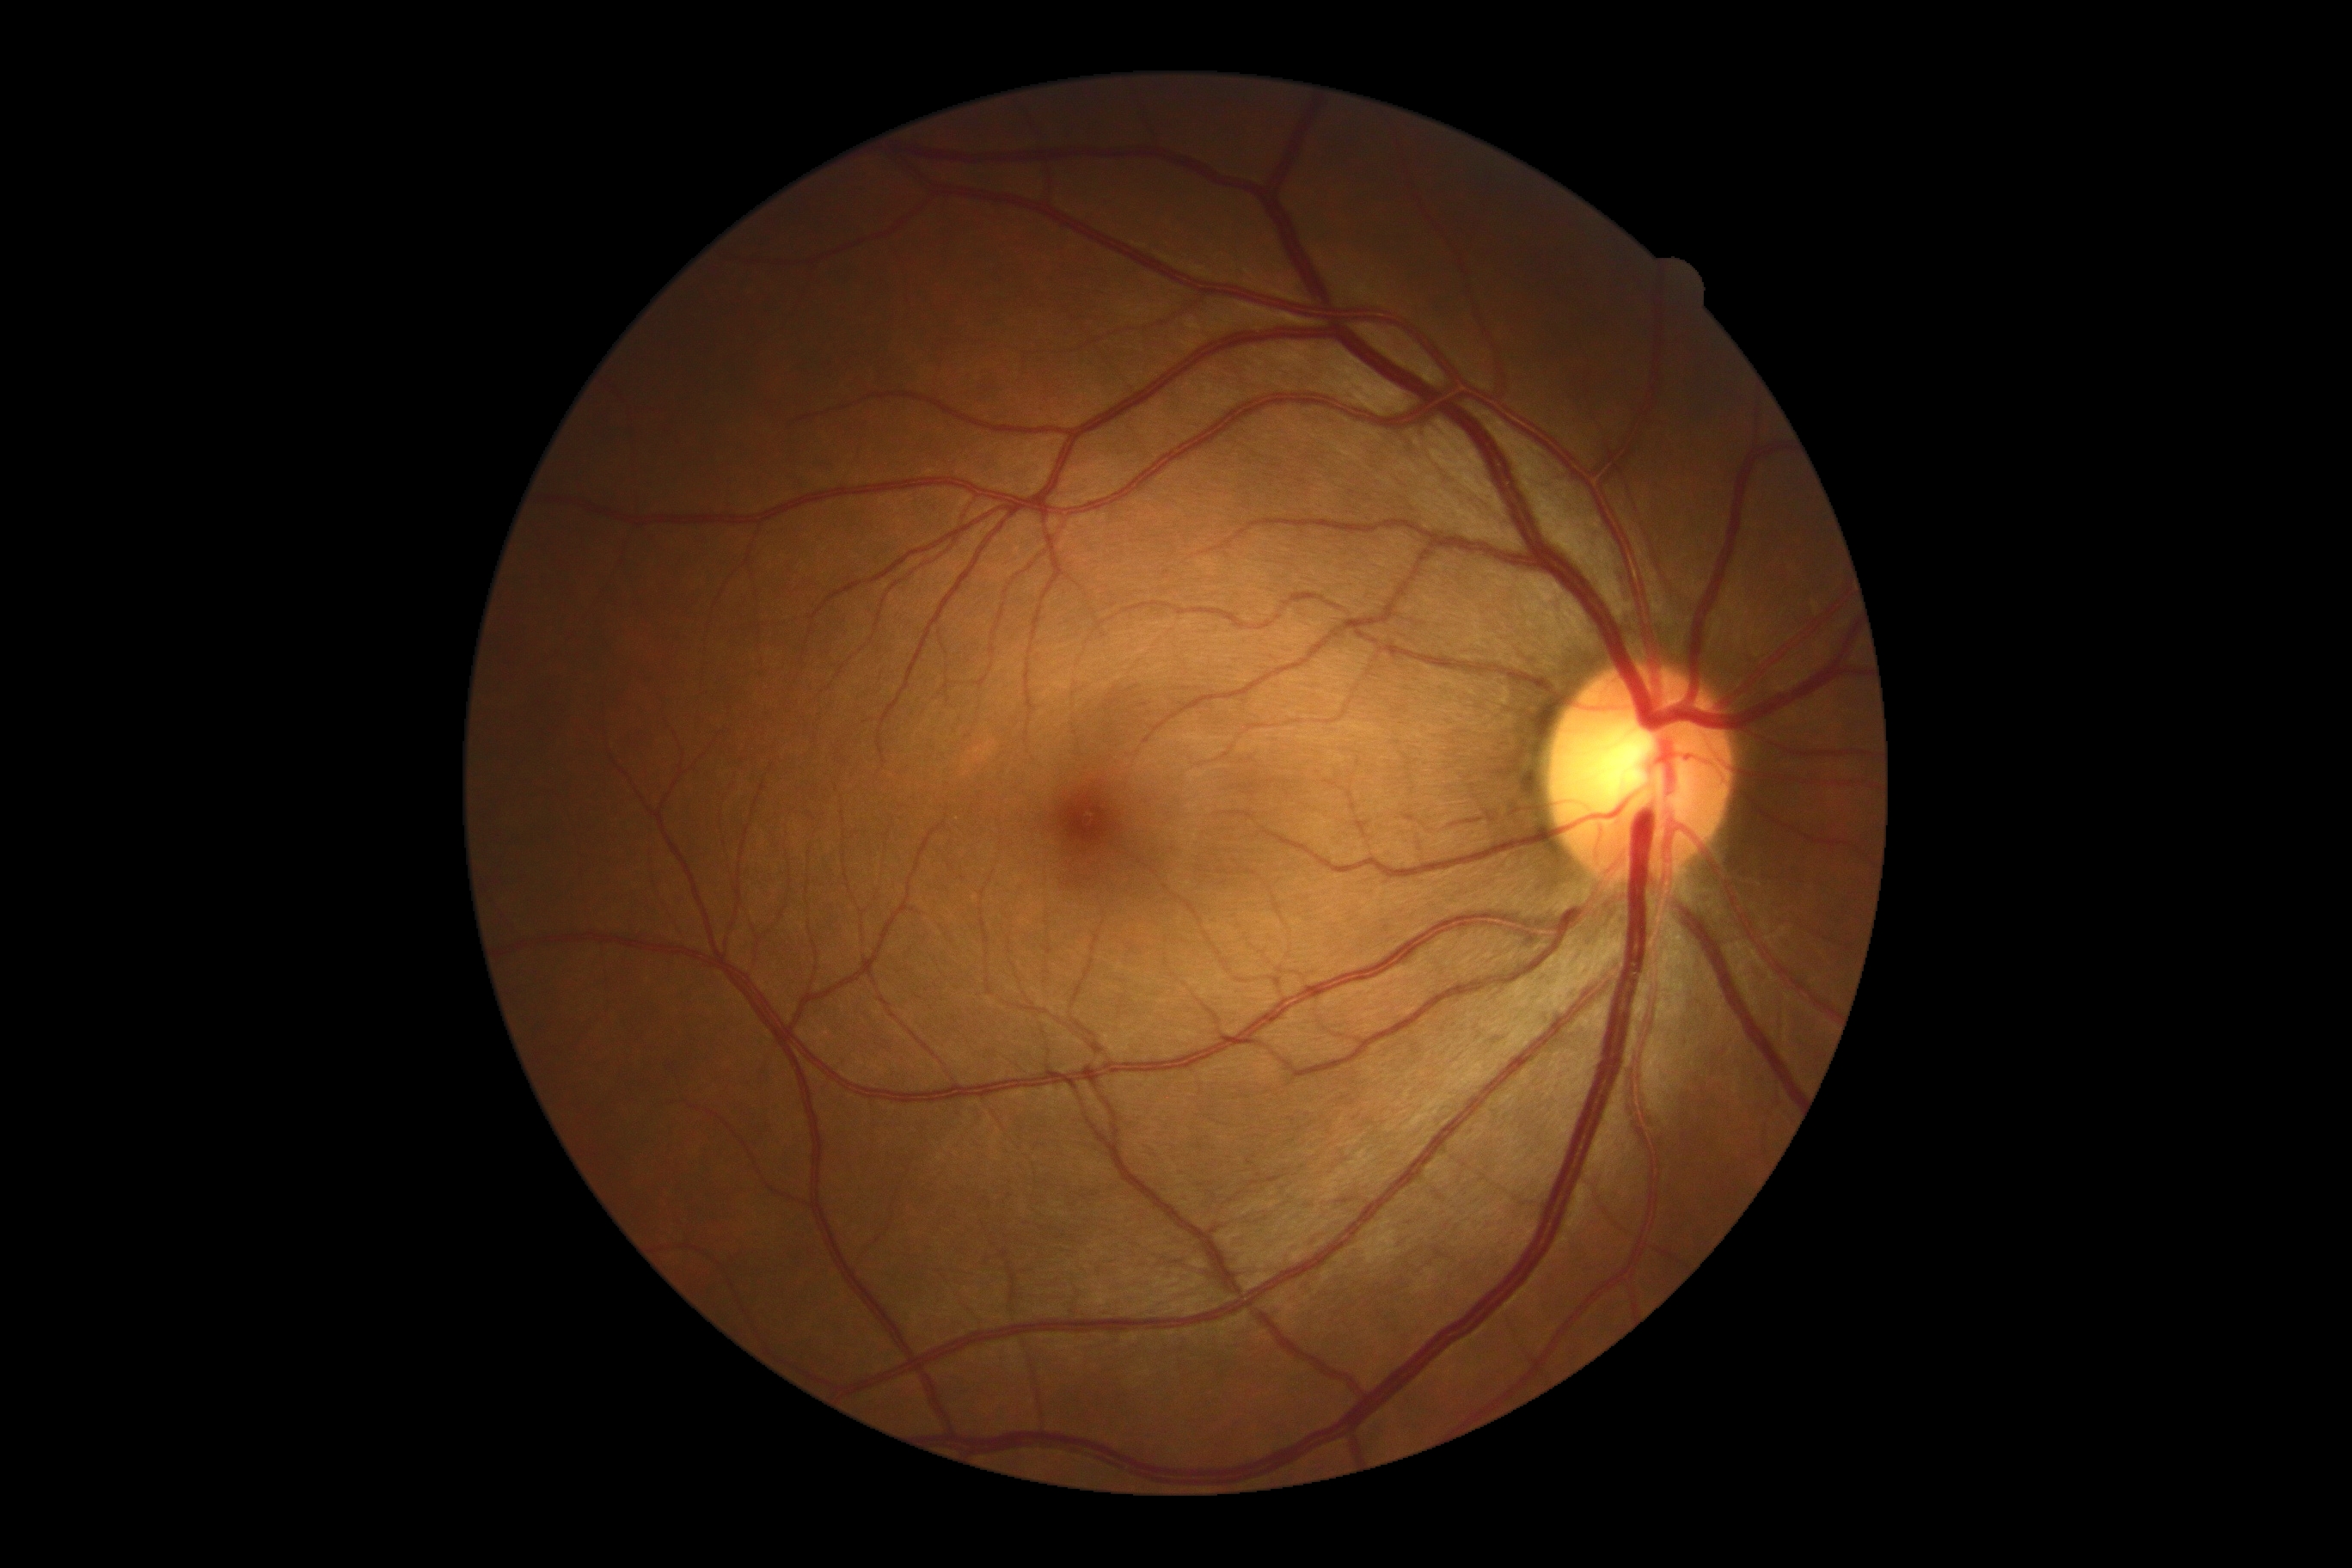 DR impression: no DR findings, DR: grade 0 (no apparent retinopathy) — no visible signs of diabetic retinopathy.